Image size 1240x1240. Infant wide-field retinal image: 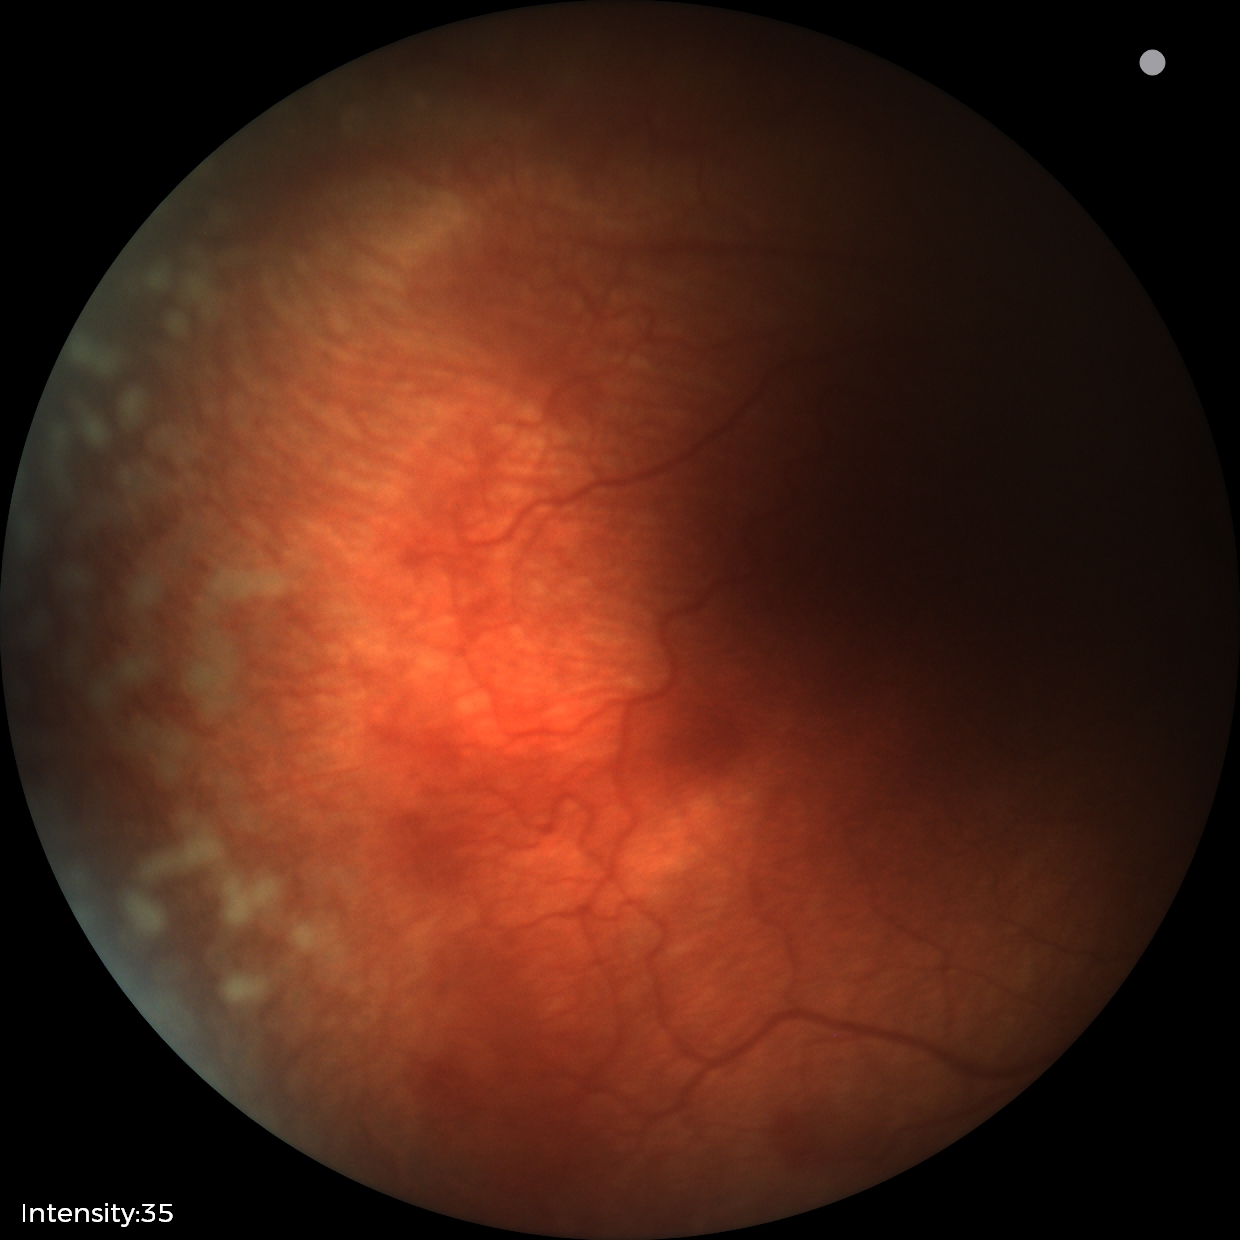

From an examination with diagnosis of retinopathy of prematurity stage 2.